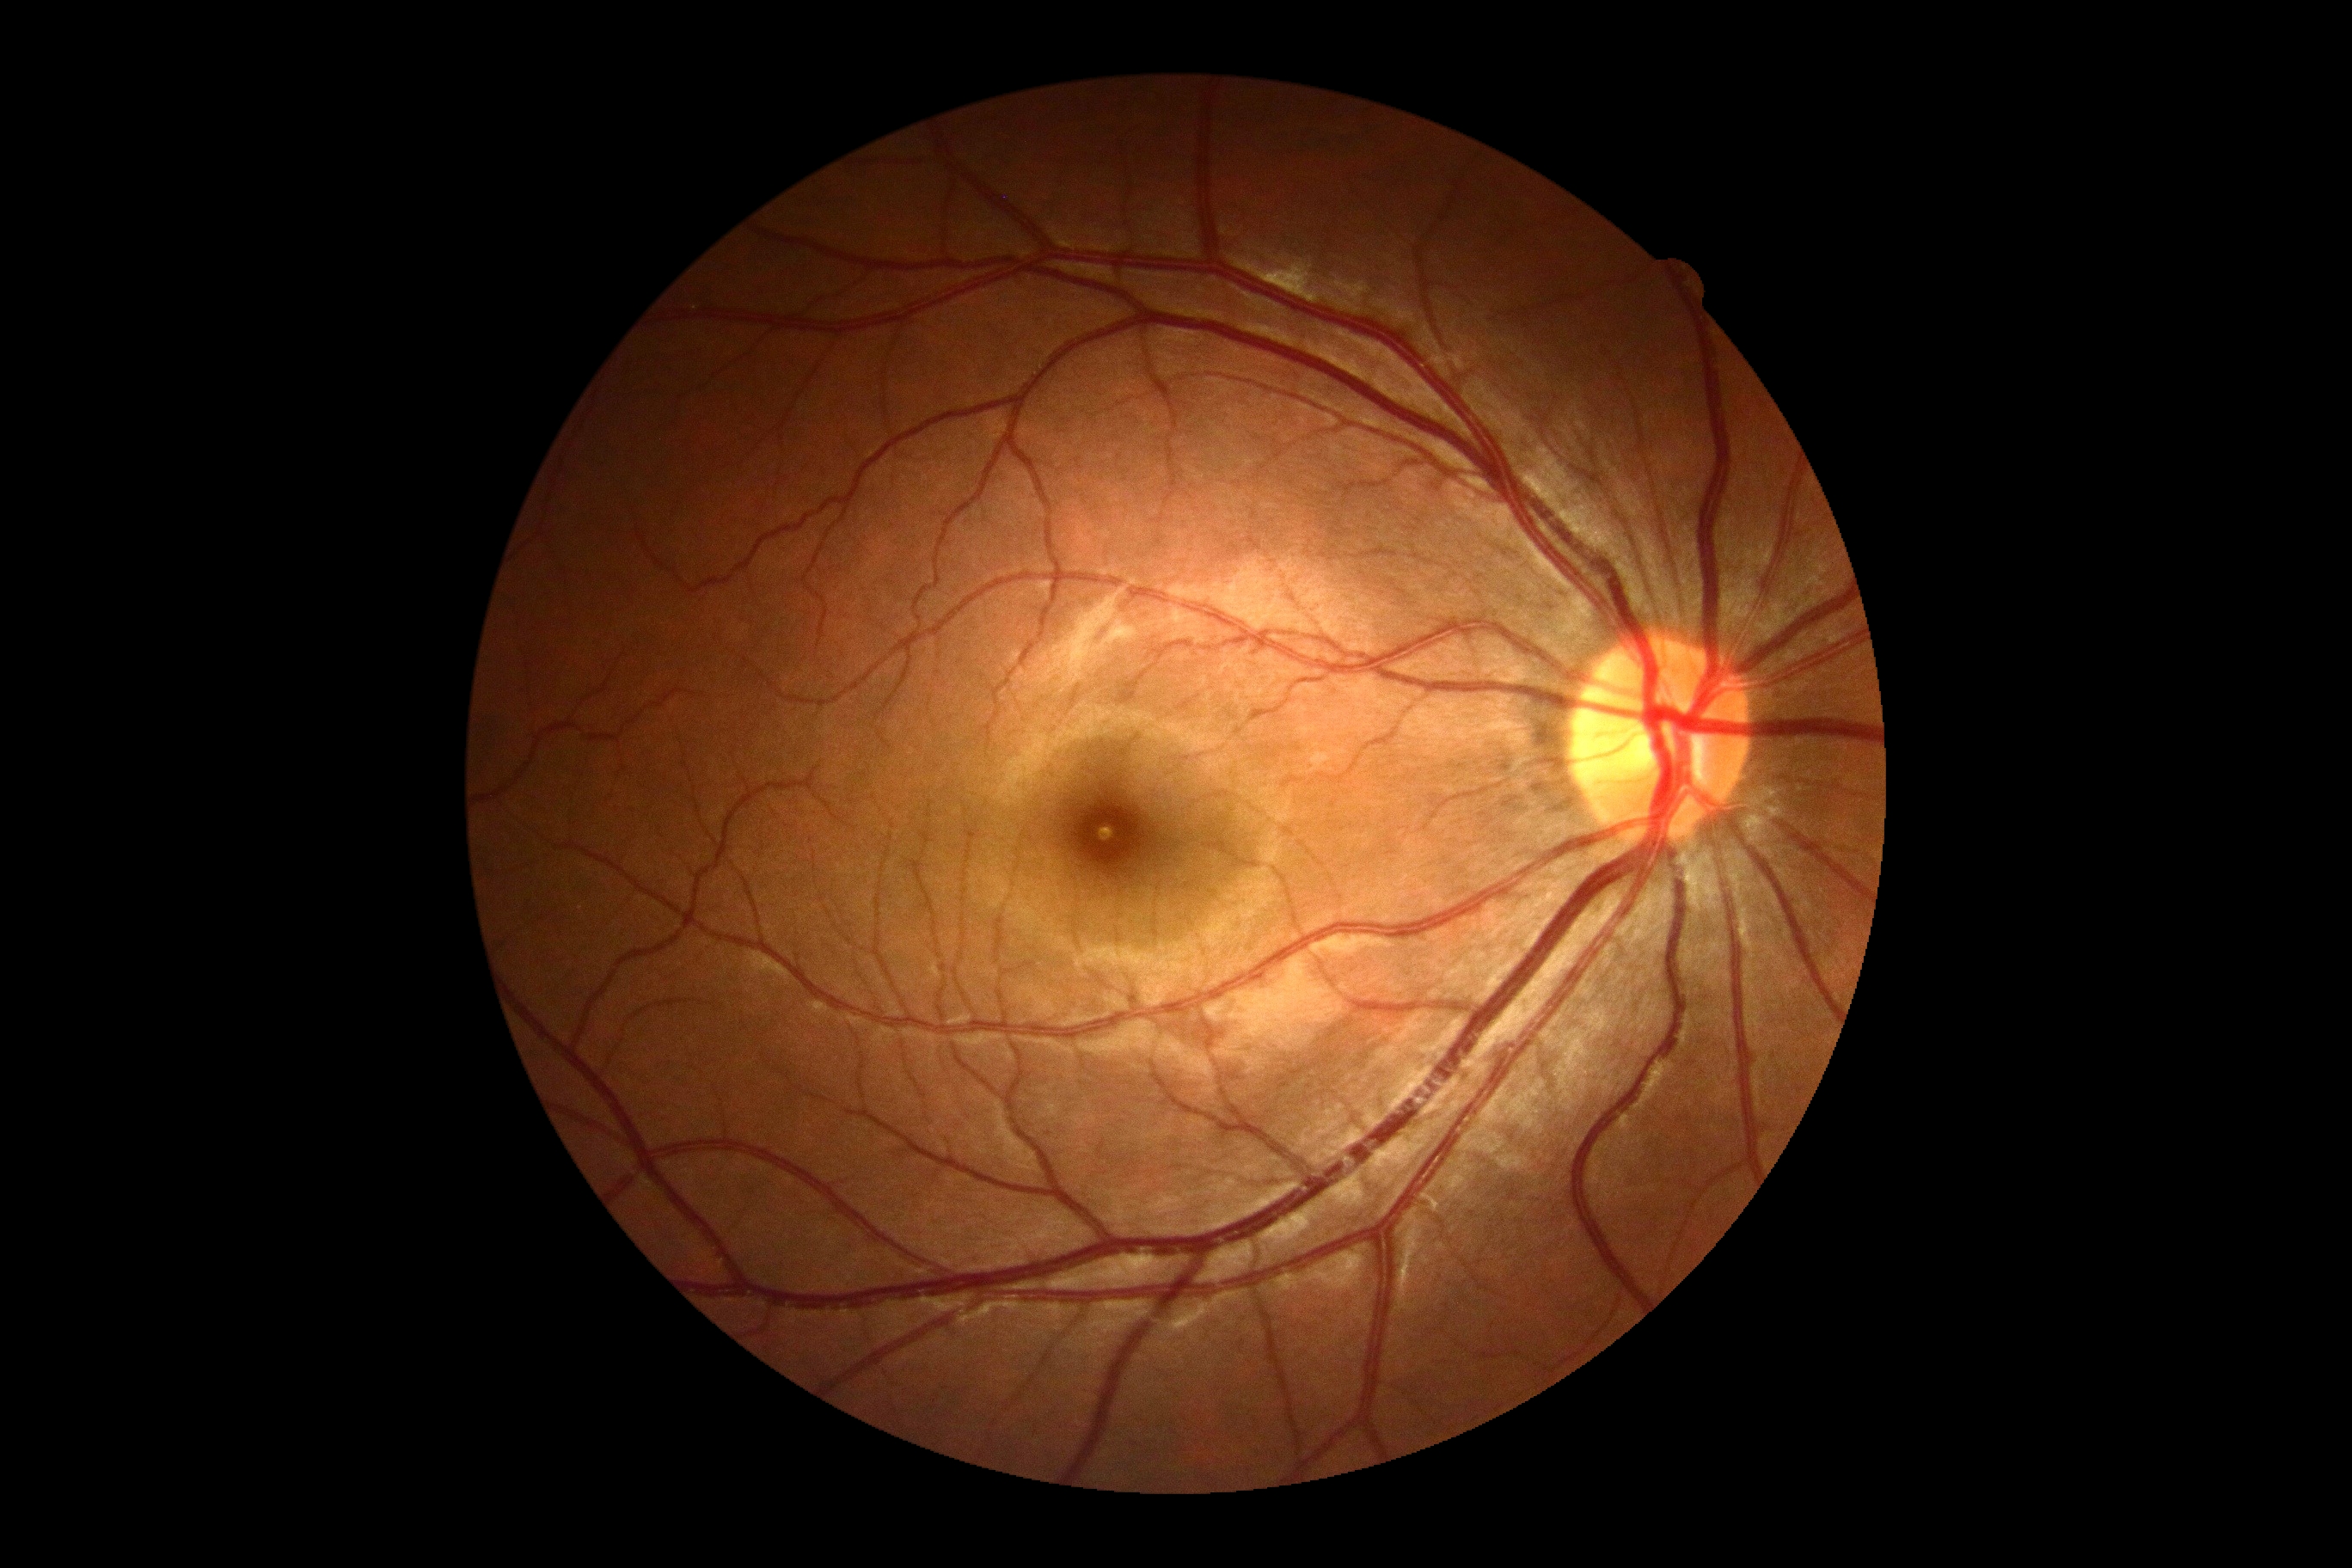 DR stage: grade 0 (no apparent retinopathy).